Pediatric retinal photograph (wide-field): 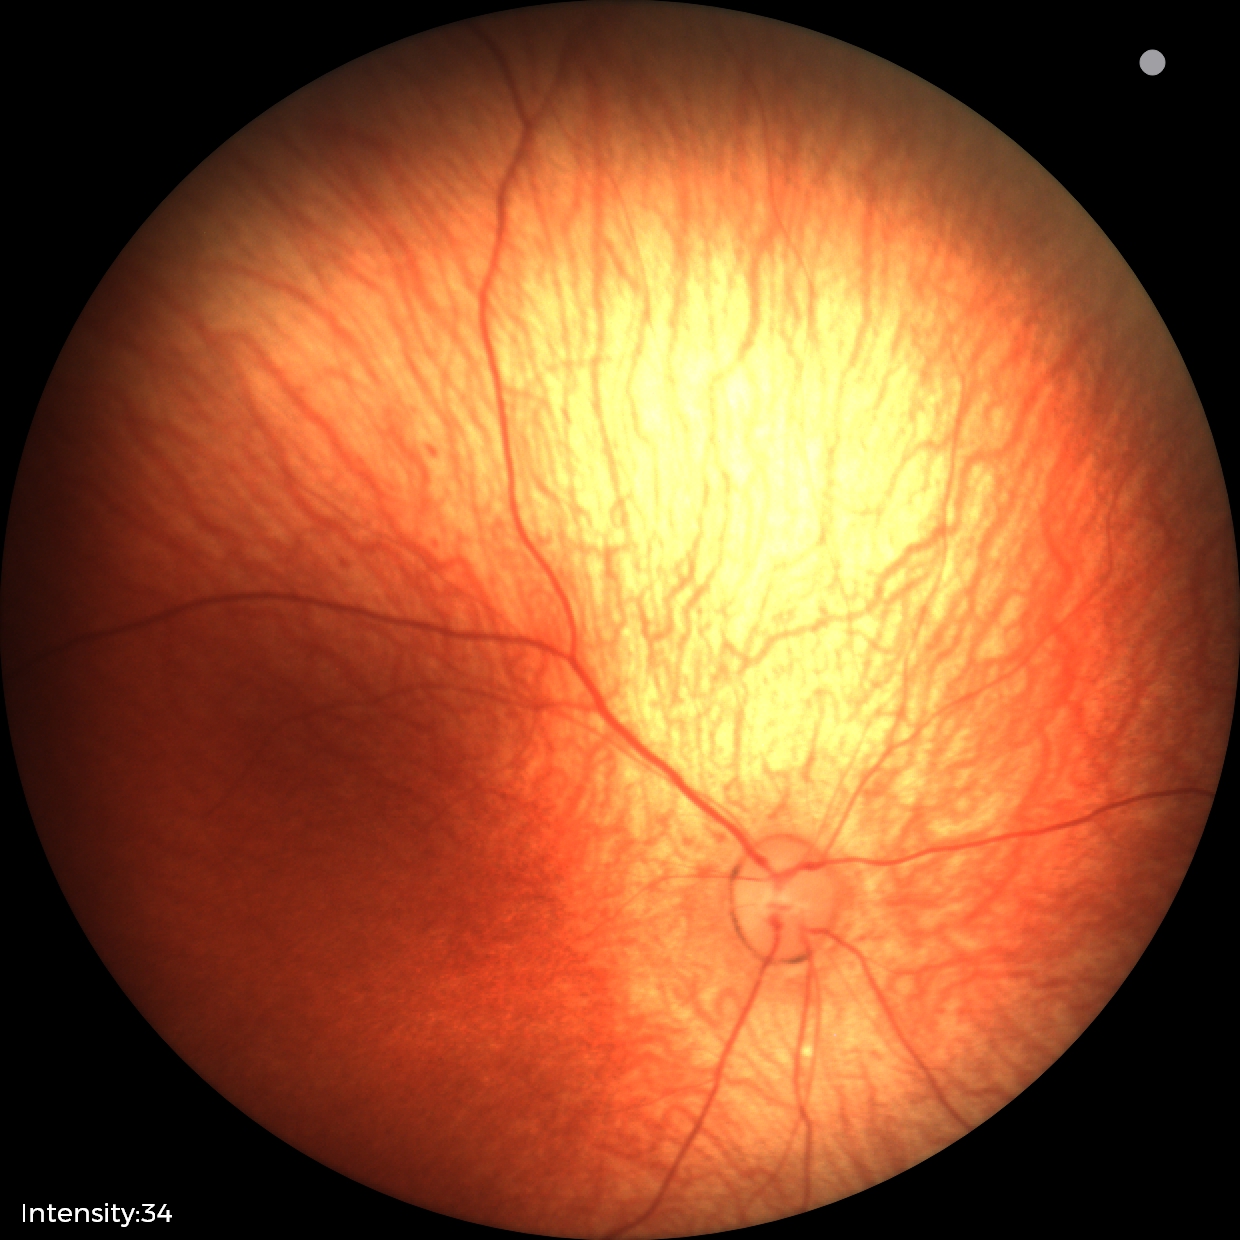
Screening: physiological appearance with no retinal pathology.